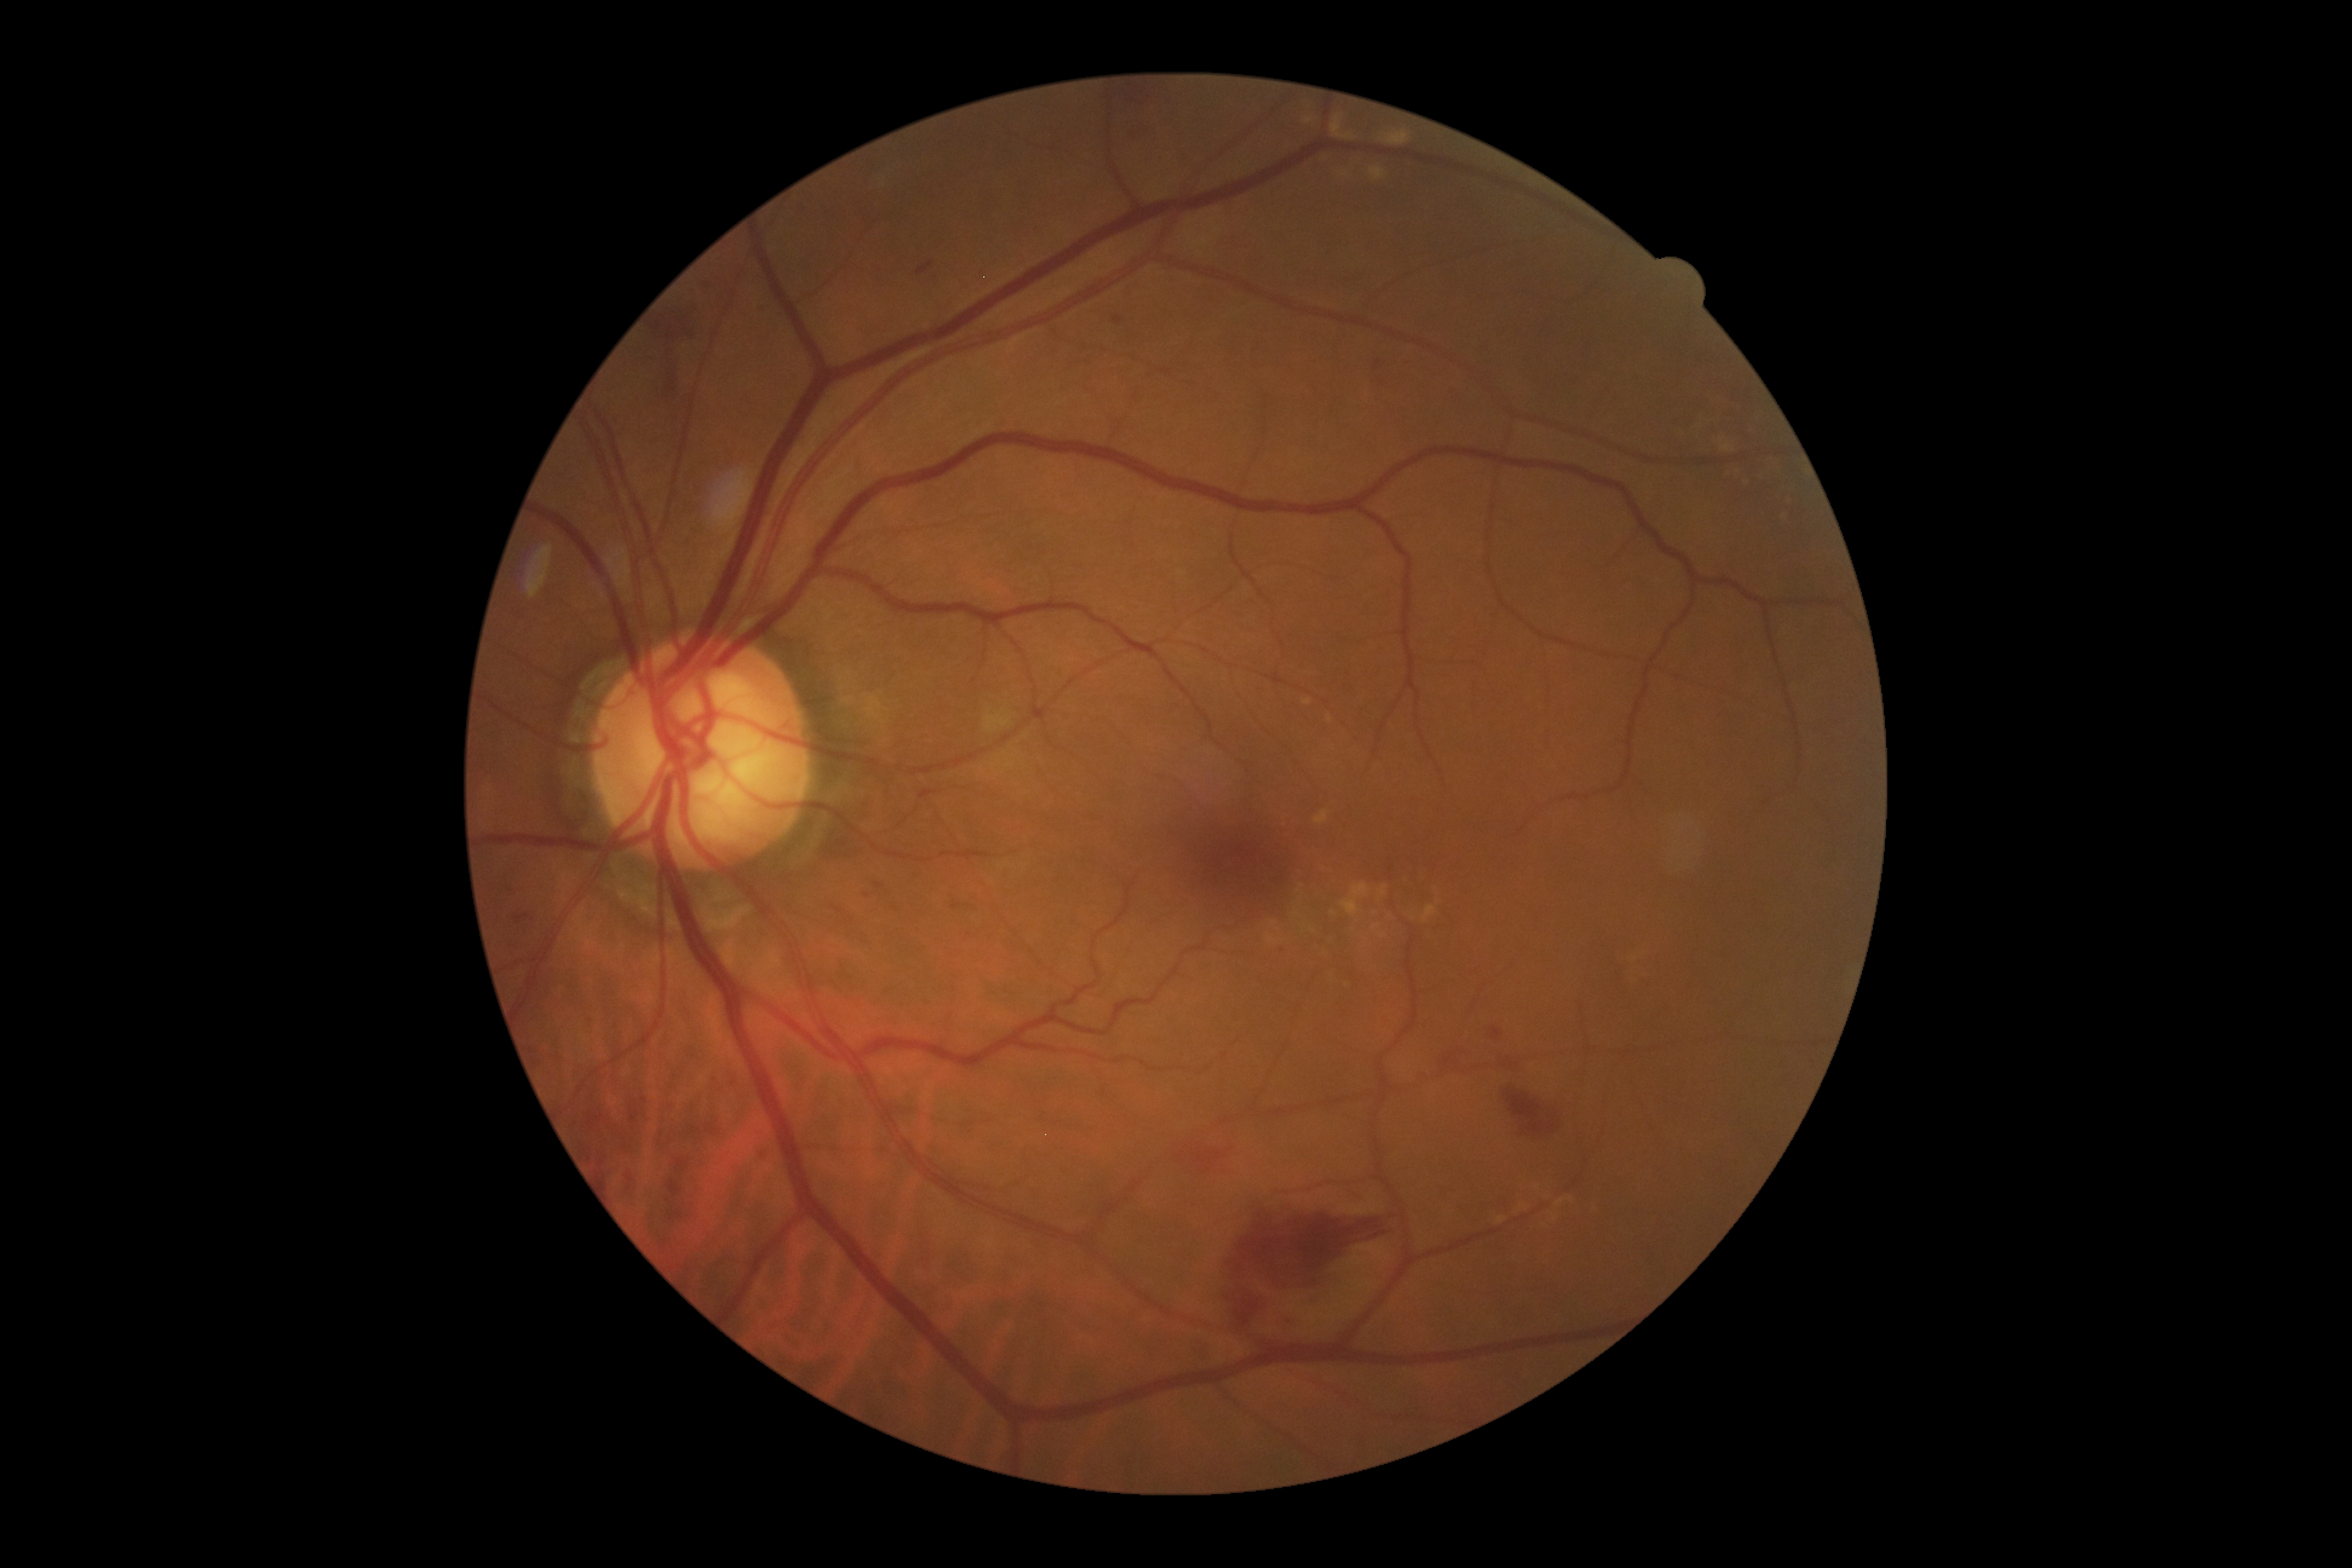   dr_grade: grade 2